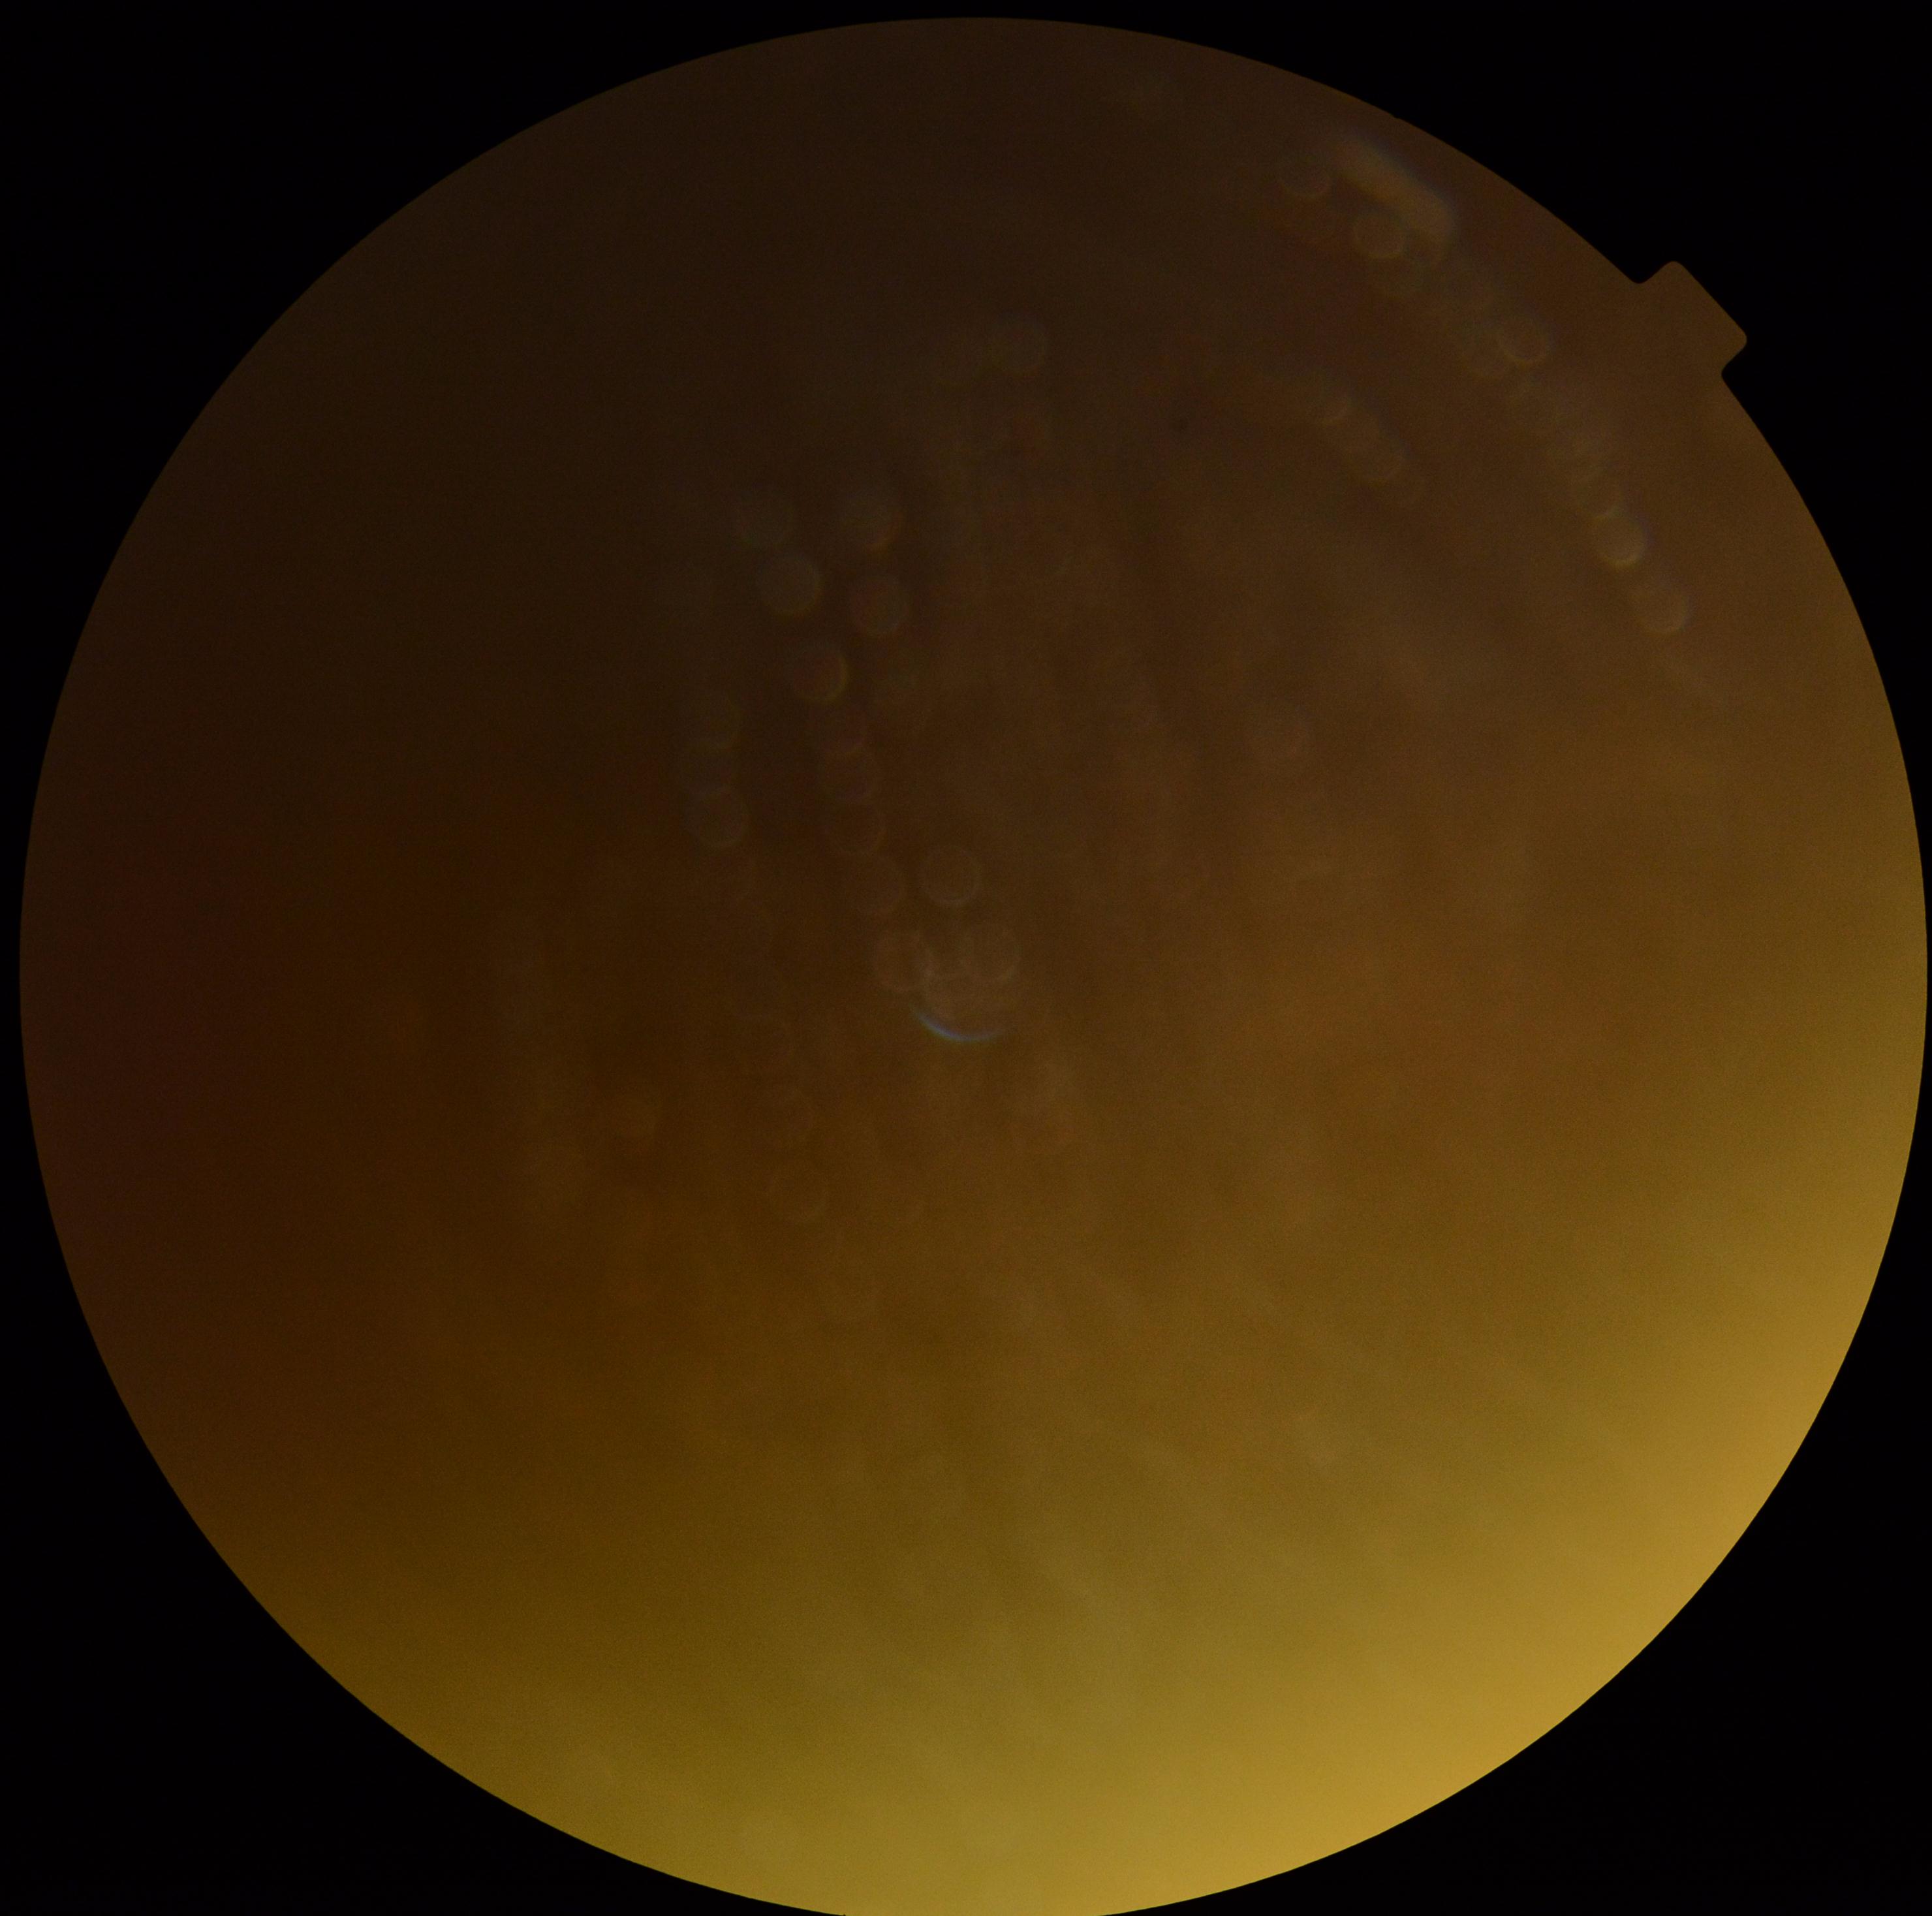

Diabetic retinopathy (DR) is ungradable due to poor image quality.